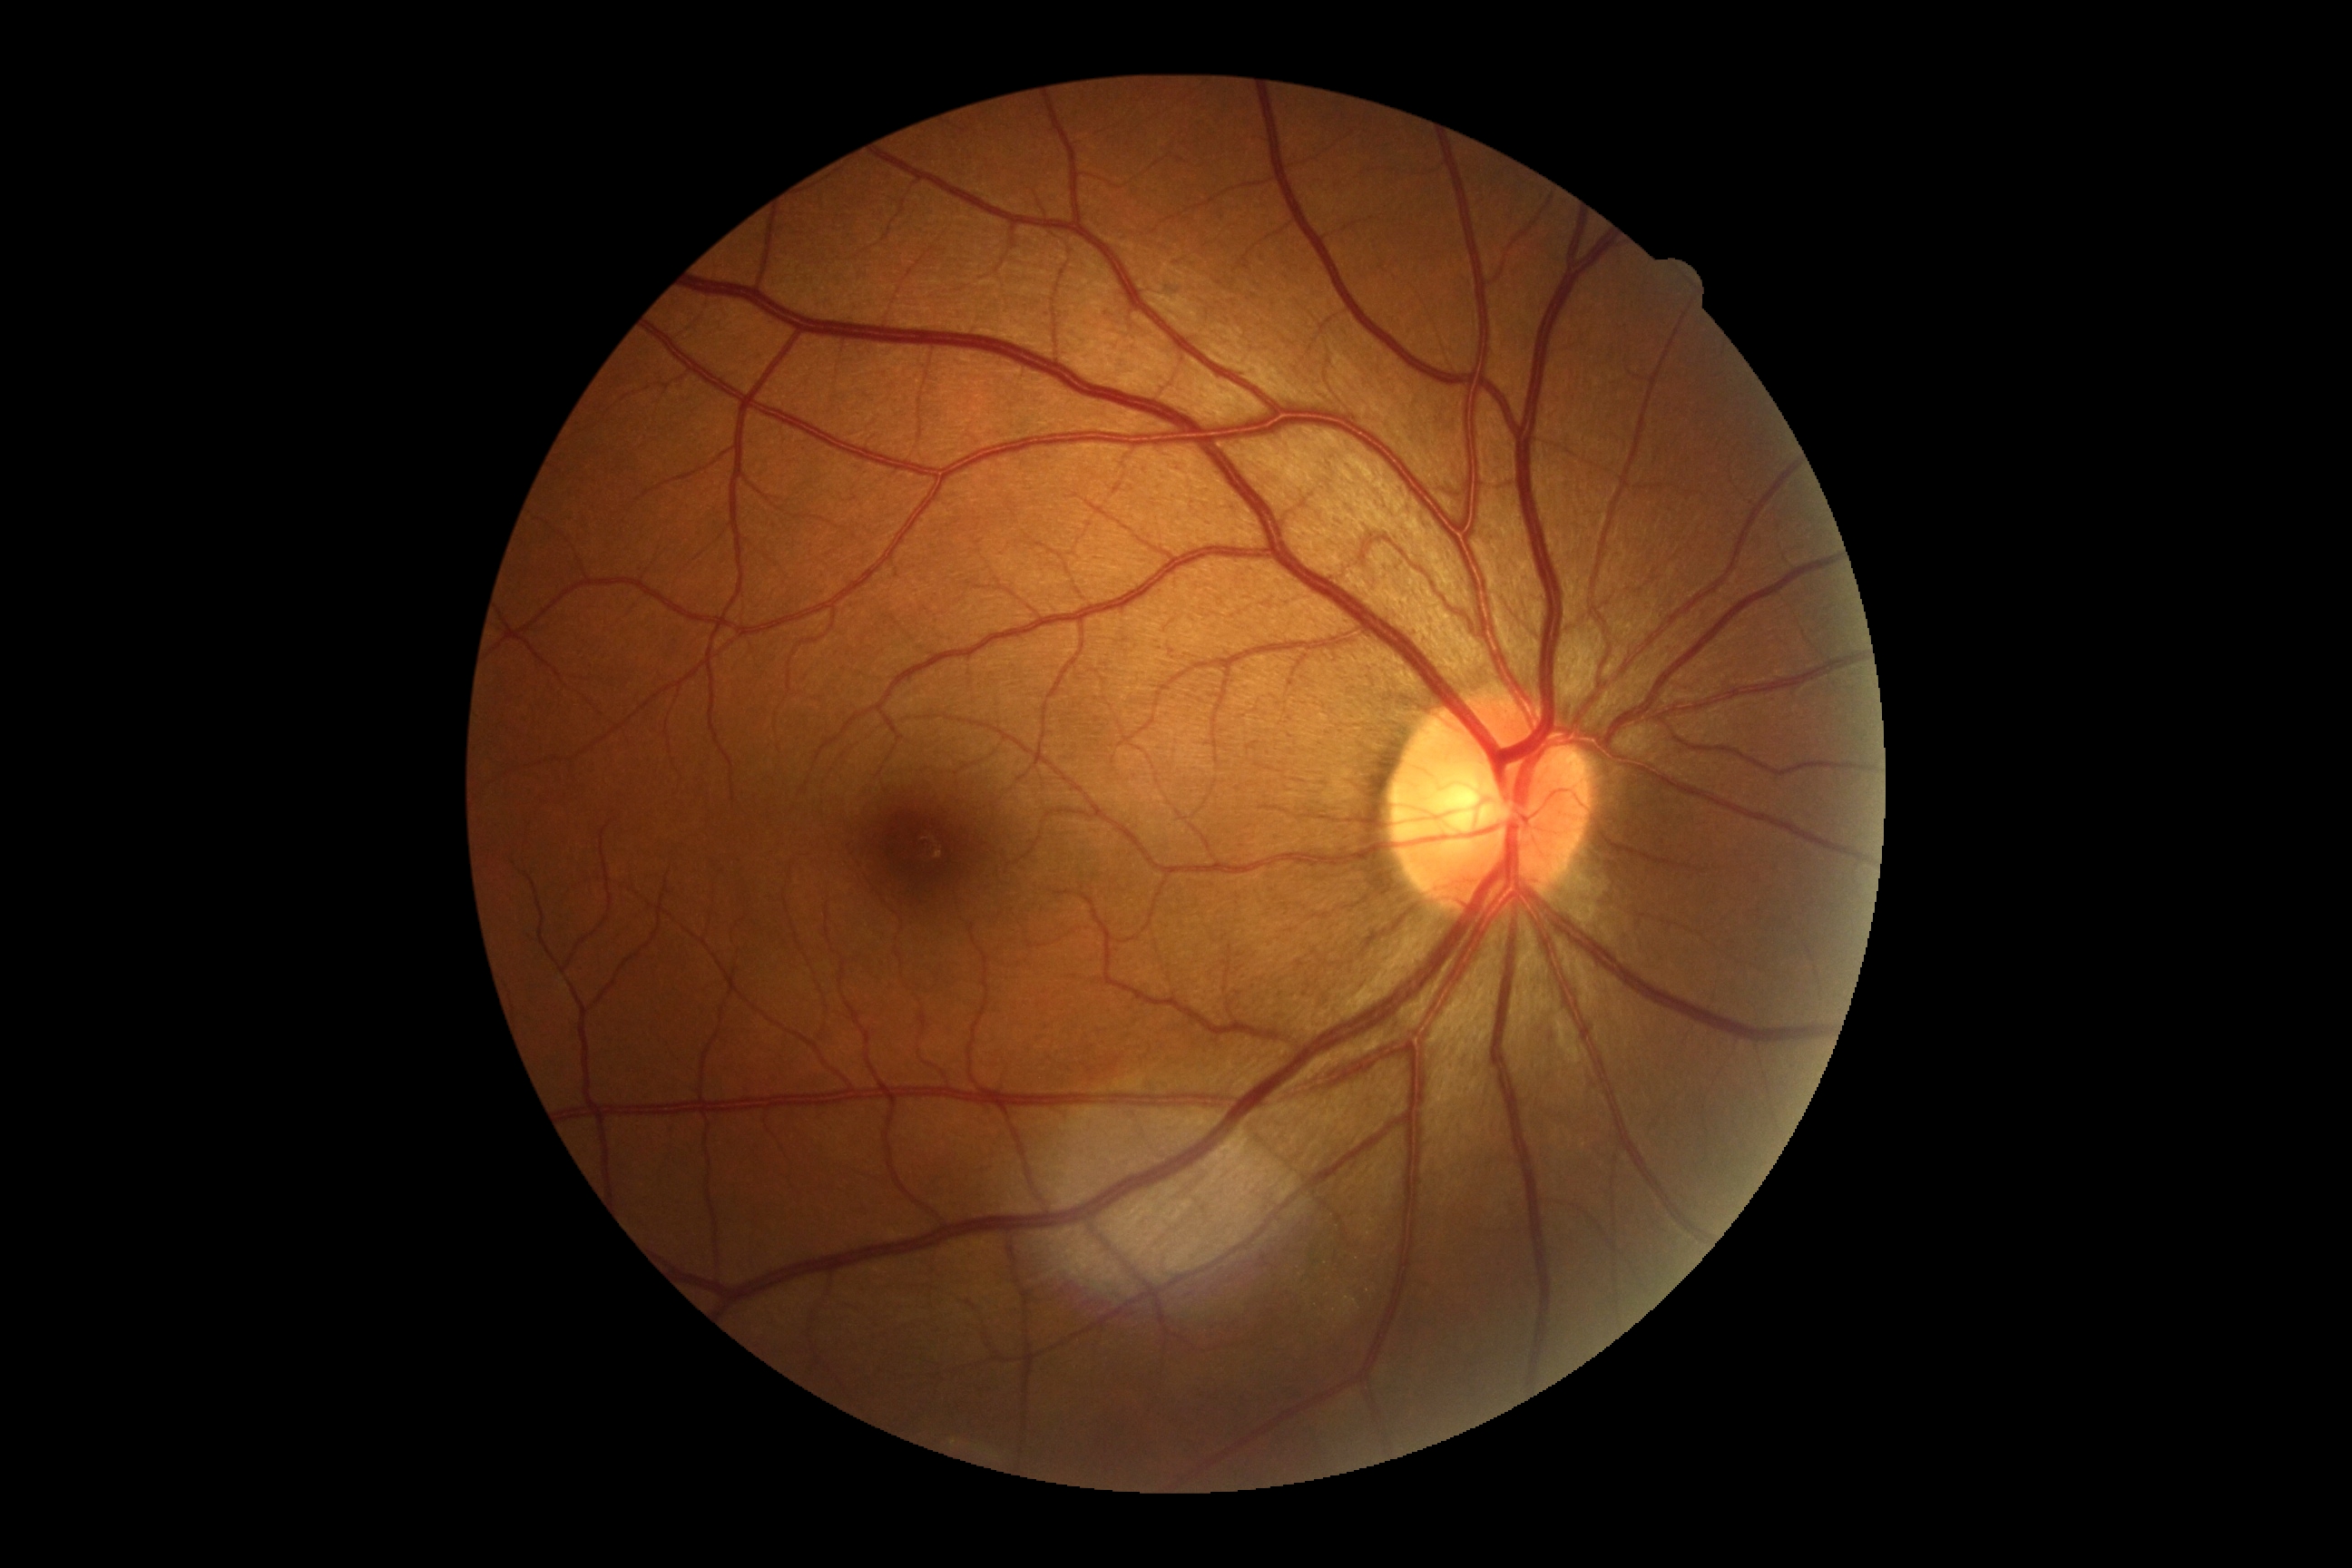
DR is grade 0 (no apparent retinopathy).